Phoenix ICON, 100° FOV · wide-field fundus photograph of an infant: 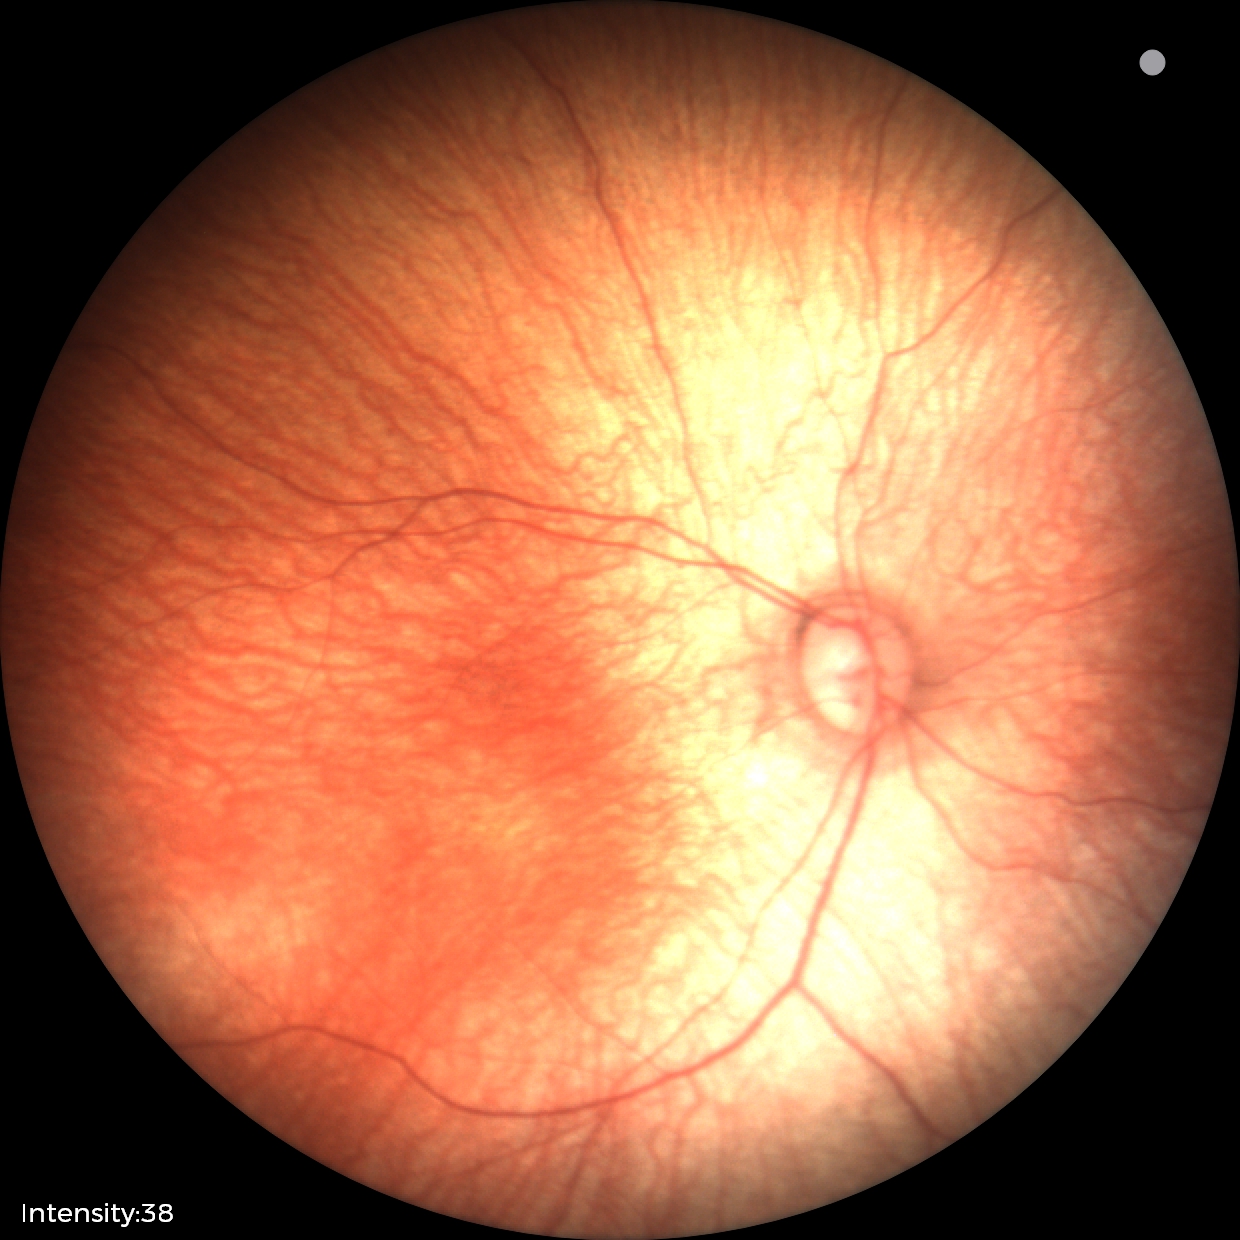

Examination with physiological retinal findings.